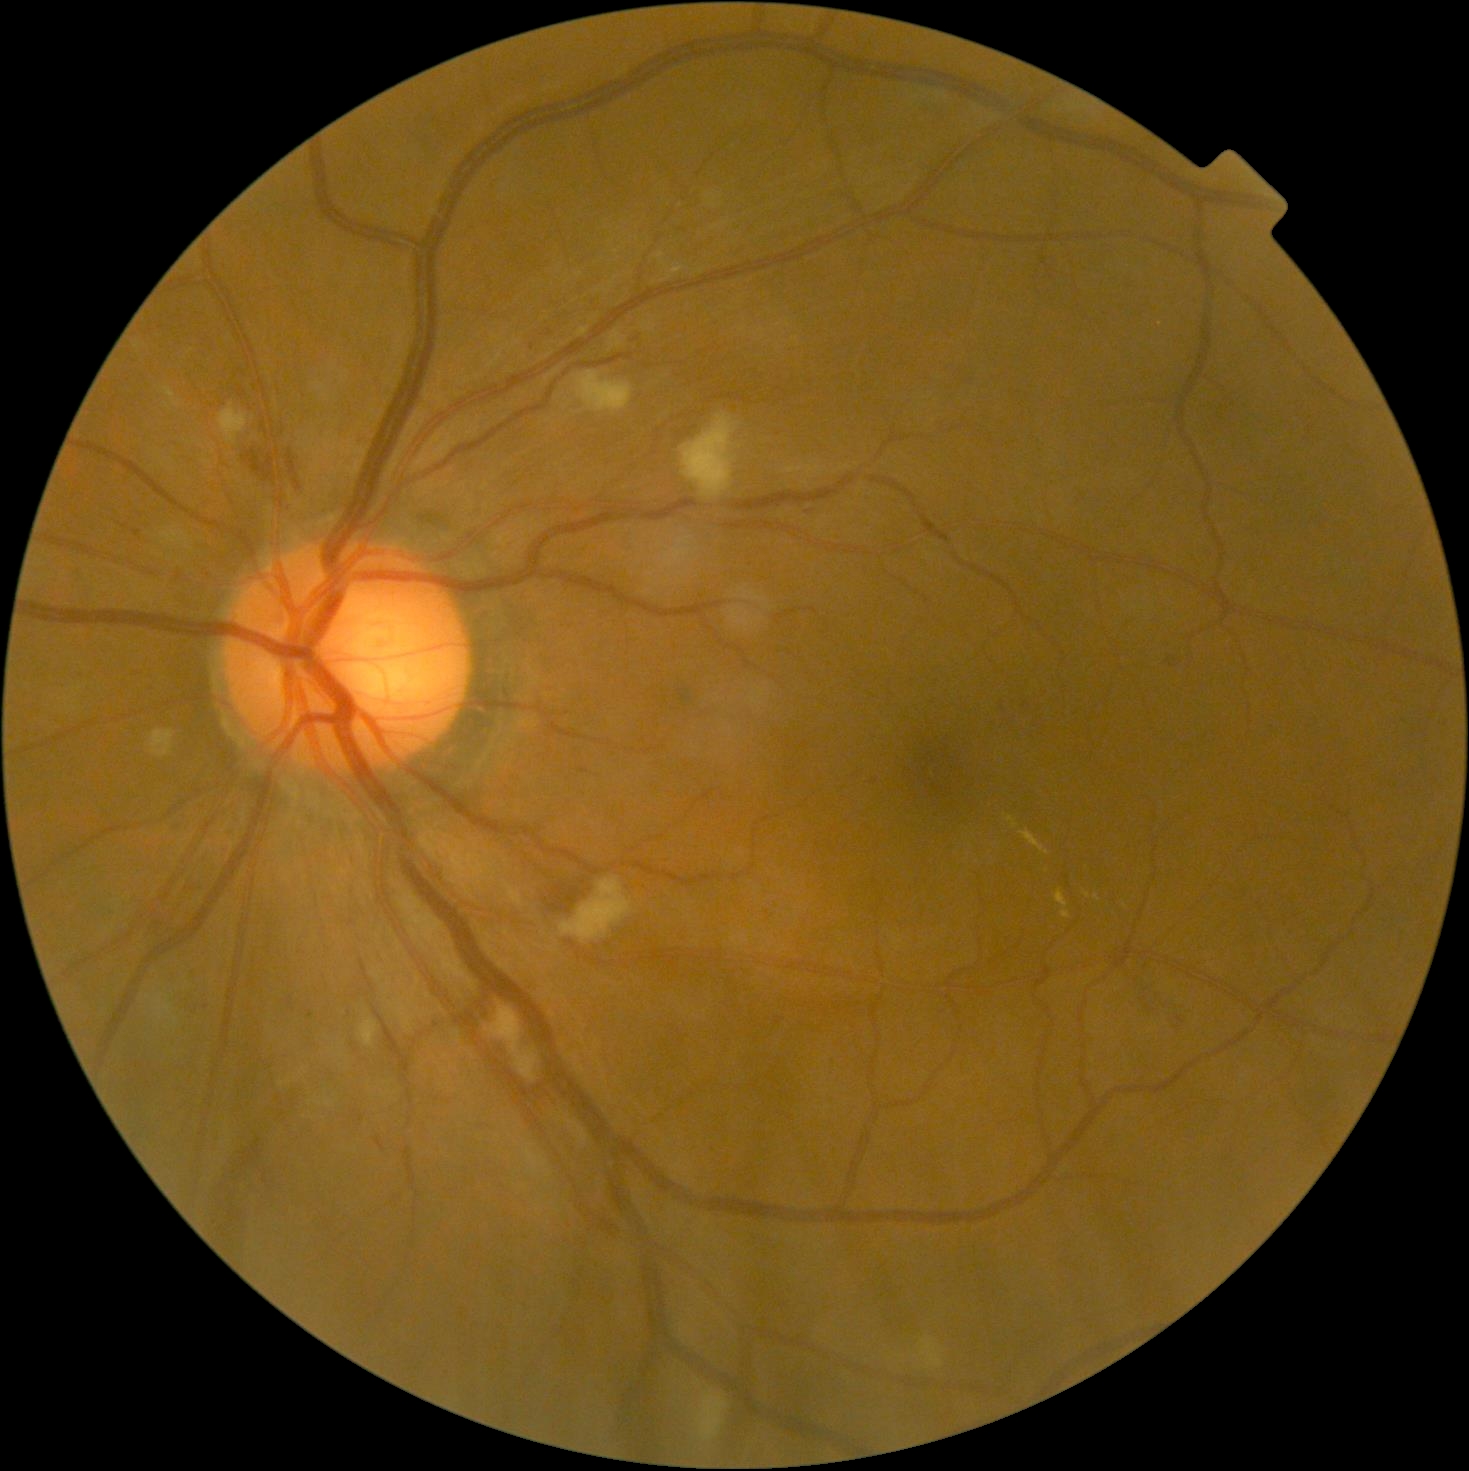
DR: moderate NPDR (grade 2).